2048x1536
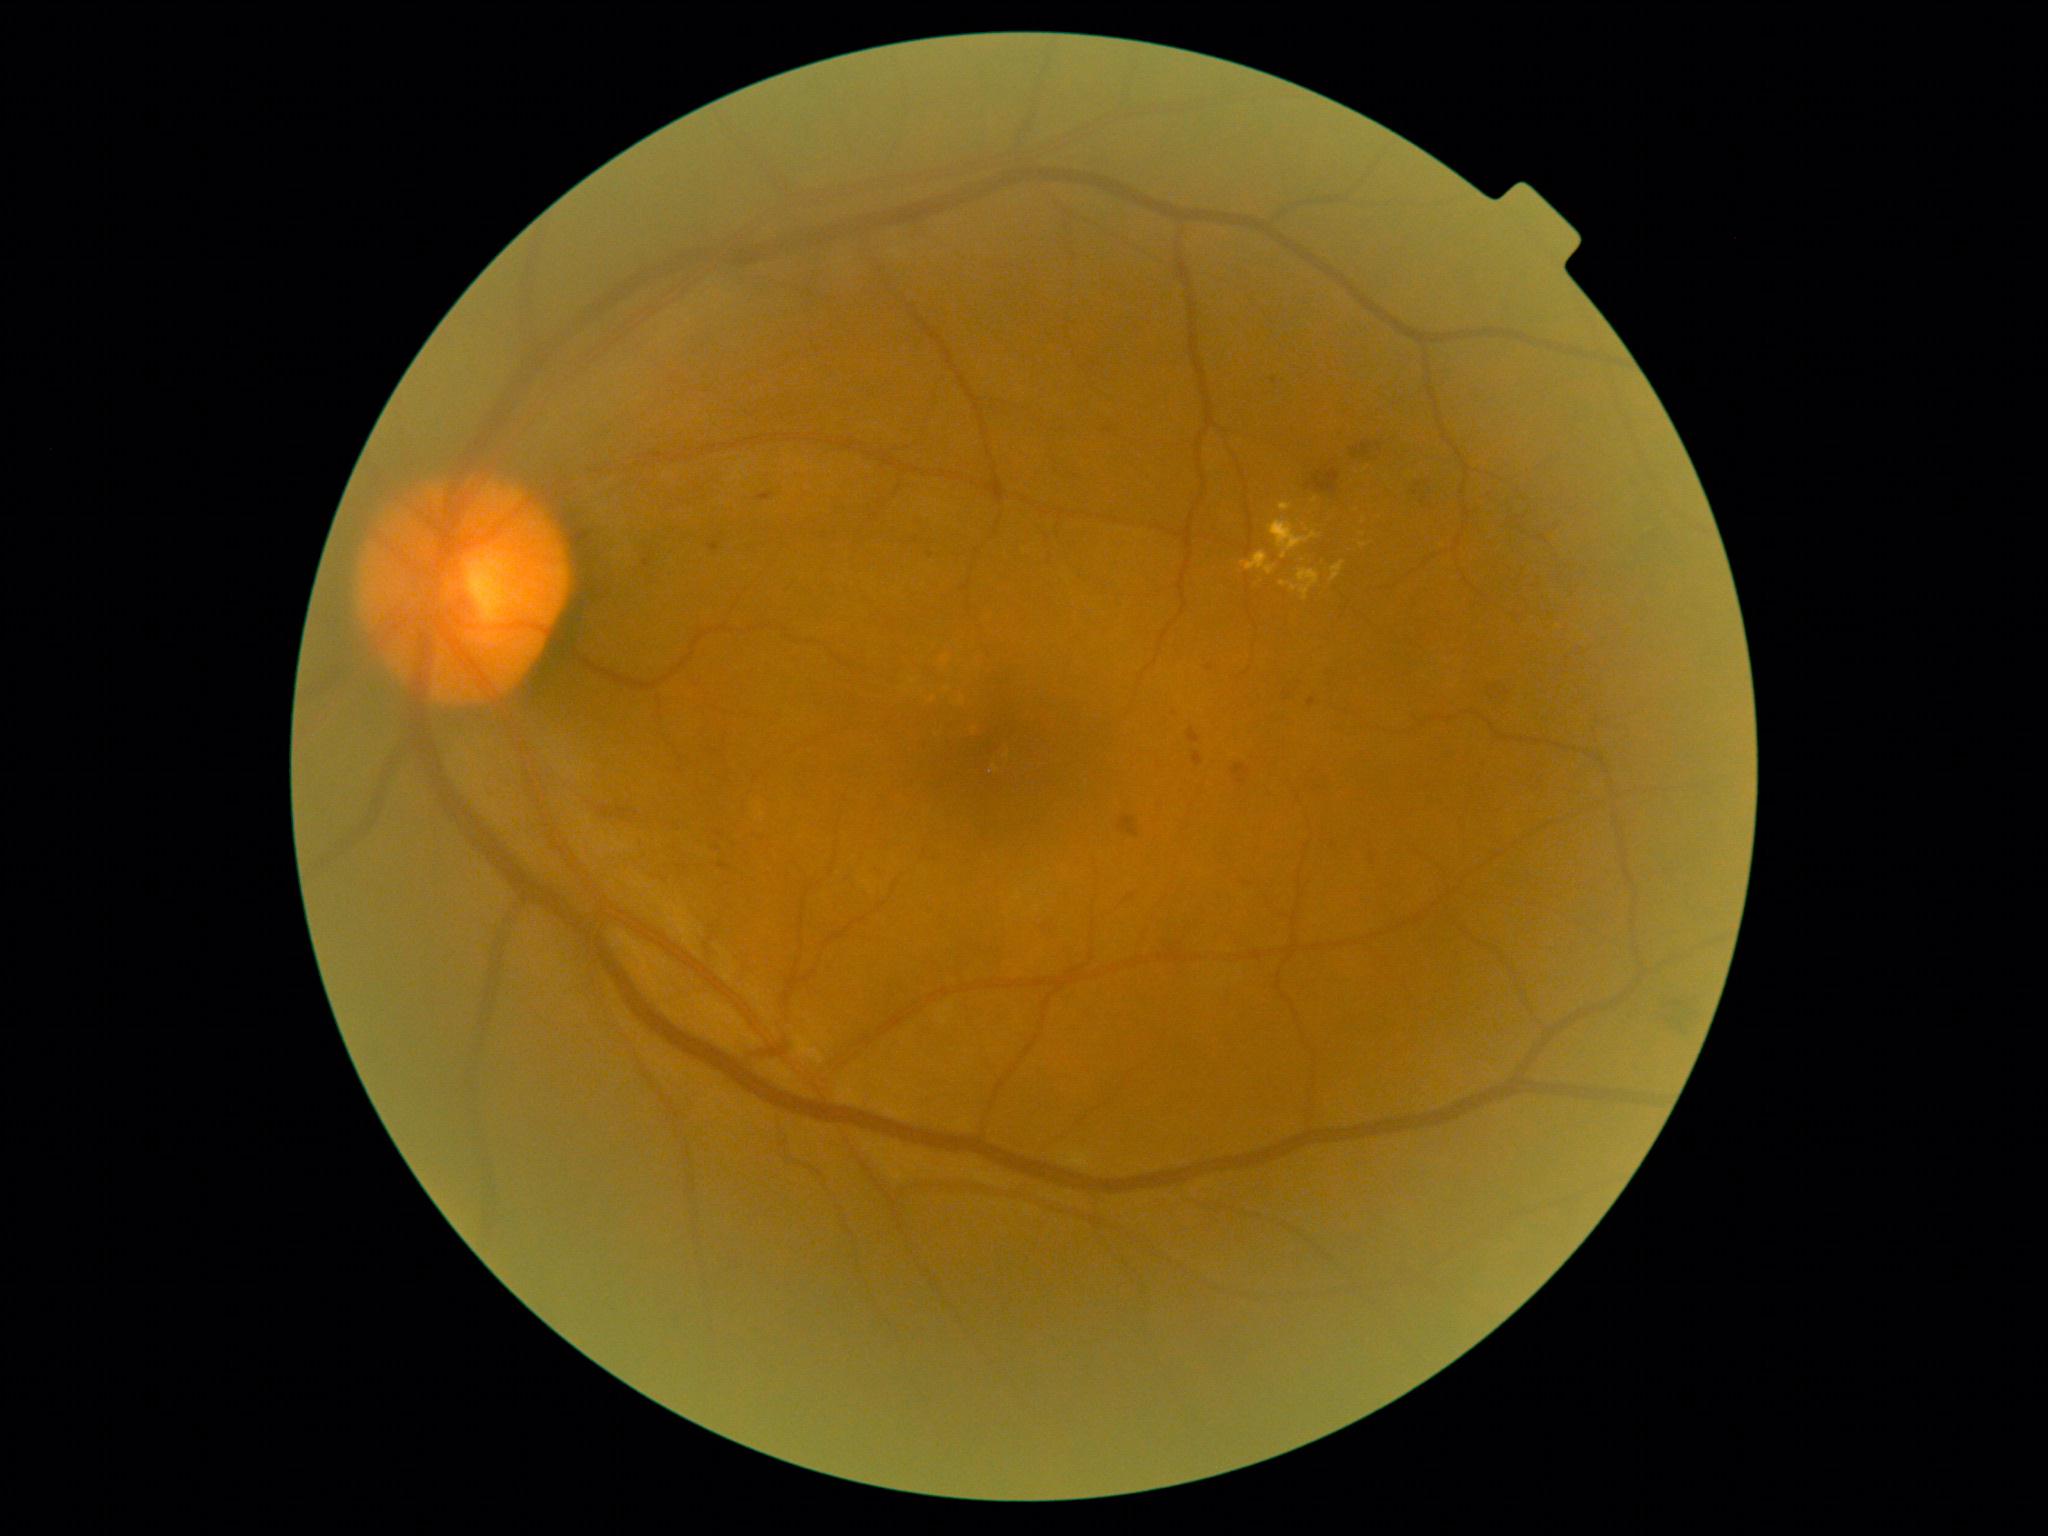

partial: true
dr_grade: 2
dr_grade_name: moderate NPDR
lesions:
  ex:
    - x1=1279 y1=503 x2=1292 y2=512
    - x1=1281 y1=582 x2=1289 y2=586
    - x1=1242 y1=552 x2=1277 y2=575
    - x1=1269 y1=520 x2=1319 y2=559
    - x1=1331 y1=562 x2=1344 y2=582
    - x1=1298 y1=569 x2=1320 y2=601
  ex_small_centers:
    - point(1315, 500)
    - point(1294, 589)
    - point(1363, 545)
  he:
    - x1=1307 y1=469 x2=1341 y2=495
    - x1=1119 y1=816 x2=1140 y2=837
    - x1=1377 y1=443 x2=1383 y2=453
    - x1=1490 y1=680 x2=1515 y2=713
    - x1=1037 y1=922 x2=1053 y2=933
    - x1=1351 y1=442 x2=1373 y2=459
    - x1=1304 y1=777 x2=1332 y2=797
    - x1=1410 y1=479 x2=1433 y2=510
  ma:
    - x1=1193 y1=753 x2=1203 y2=766
    - x1=707 y1=542 x2=720 y2=552
    - x1=1308 y1=698 x2=1317 y2=708
    - x1=644 y1=559 x2=651 y2=568
    - x1=762 y1=492 x2=773 y2=496
    - x1=719 y1=863 x2=731 y2=870
    - x1=1235 y1=761 x2=1245 y2=774
    - x1=1188 y1=728 x2=1201 y2=744
  ma_small_centers:
    - point(1209, 668)
    - point(1175, 713)
    - point(718, 849)
    - point(1274, 381)
    - point(720, 835)
  se: []